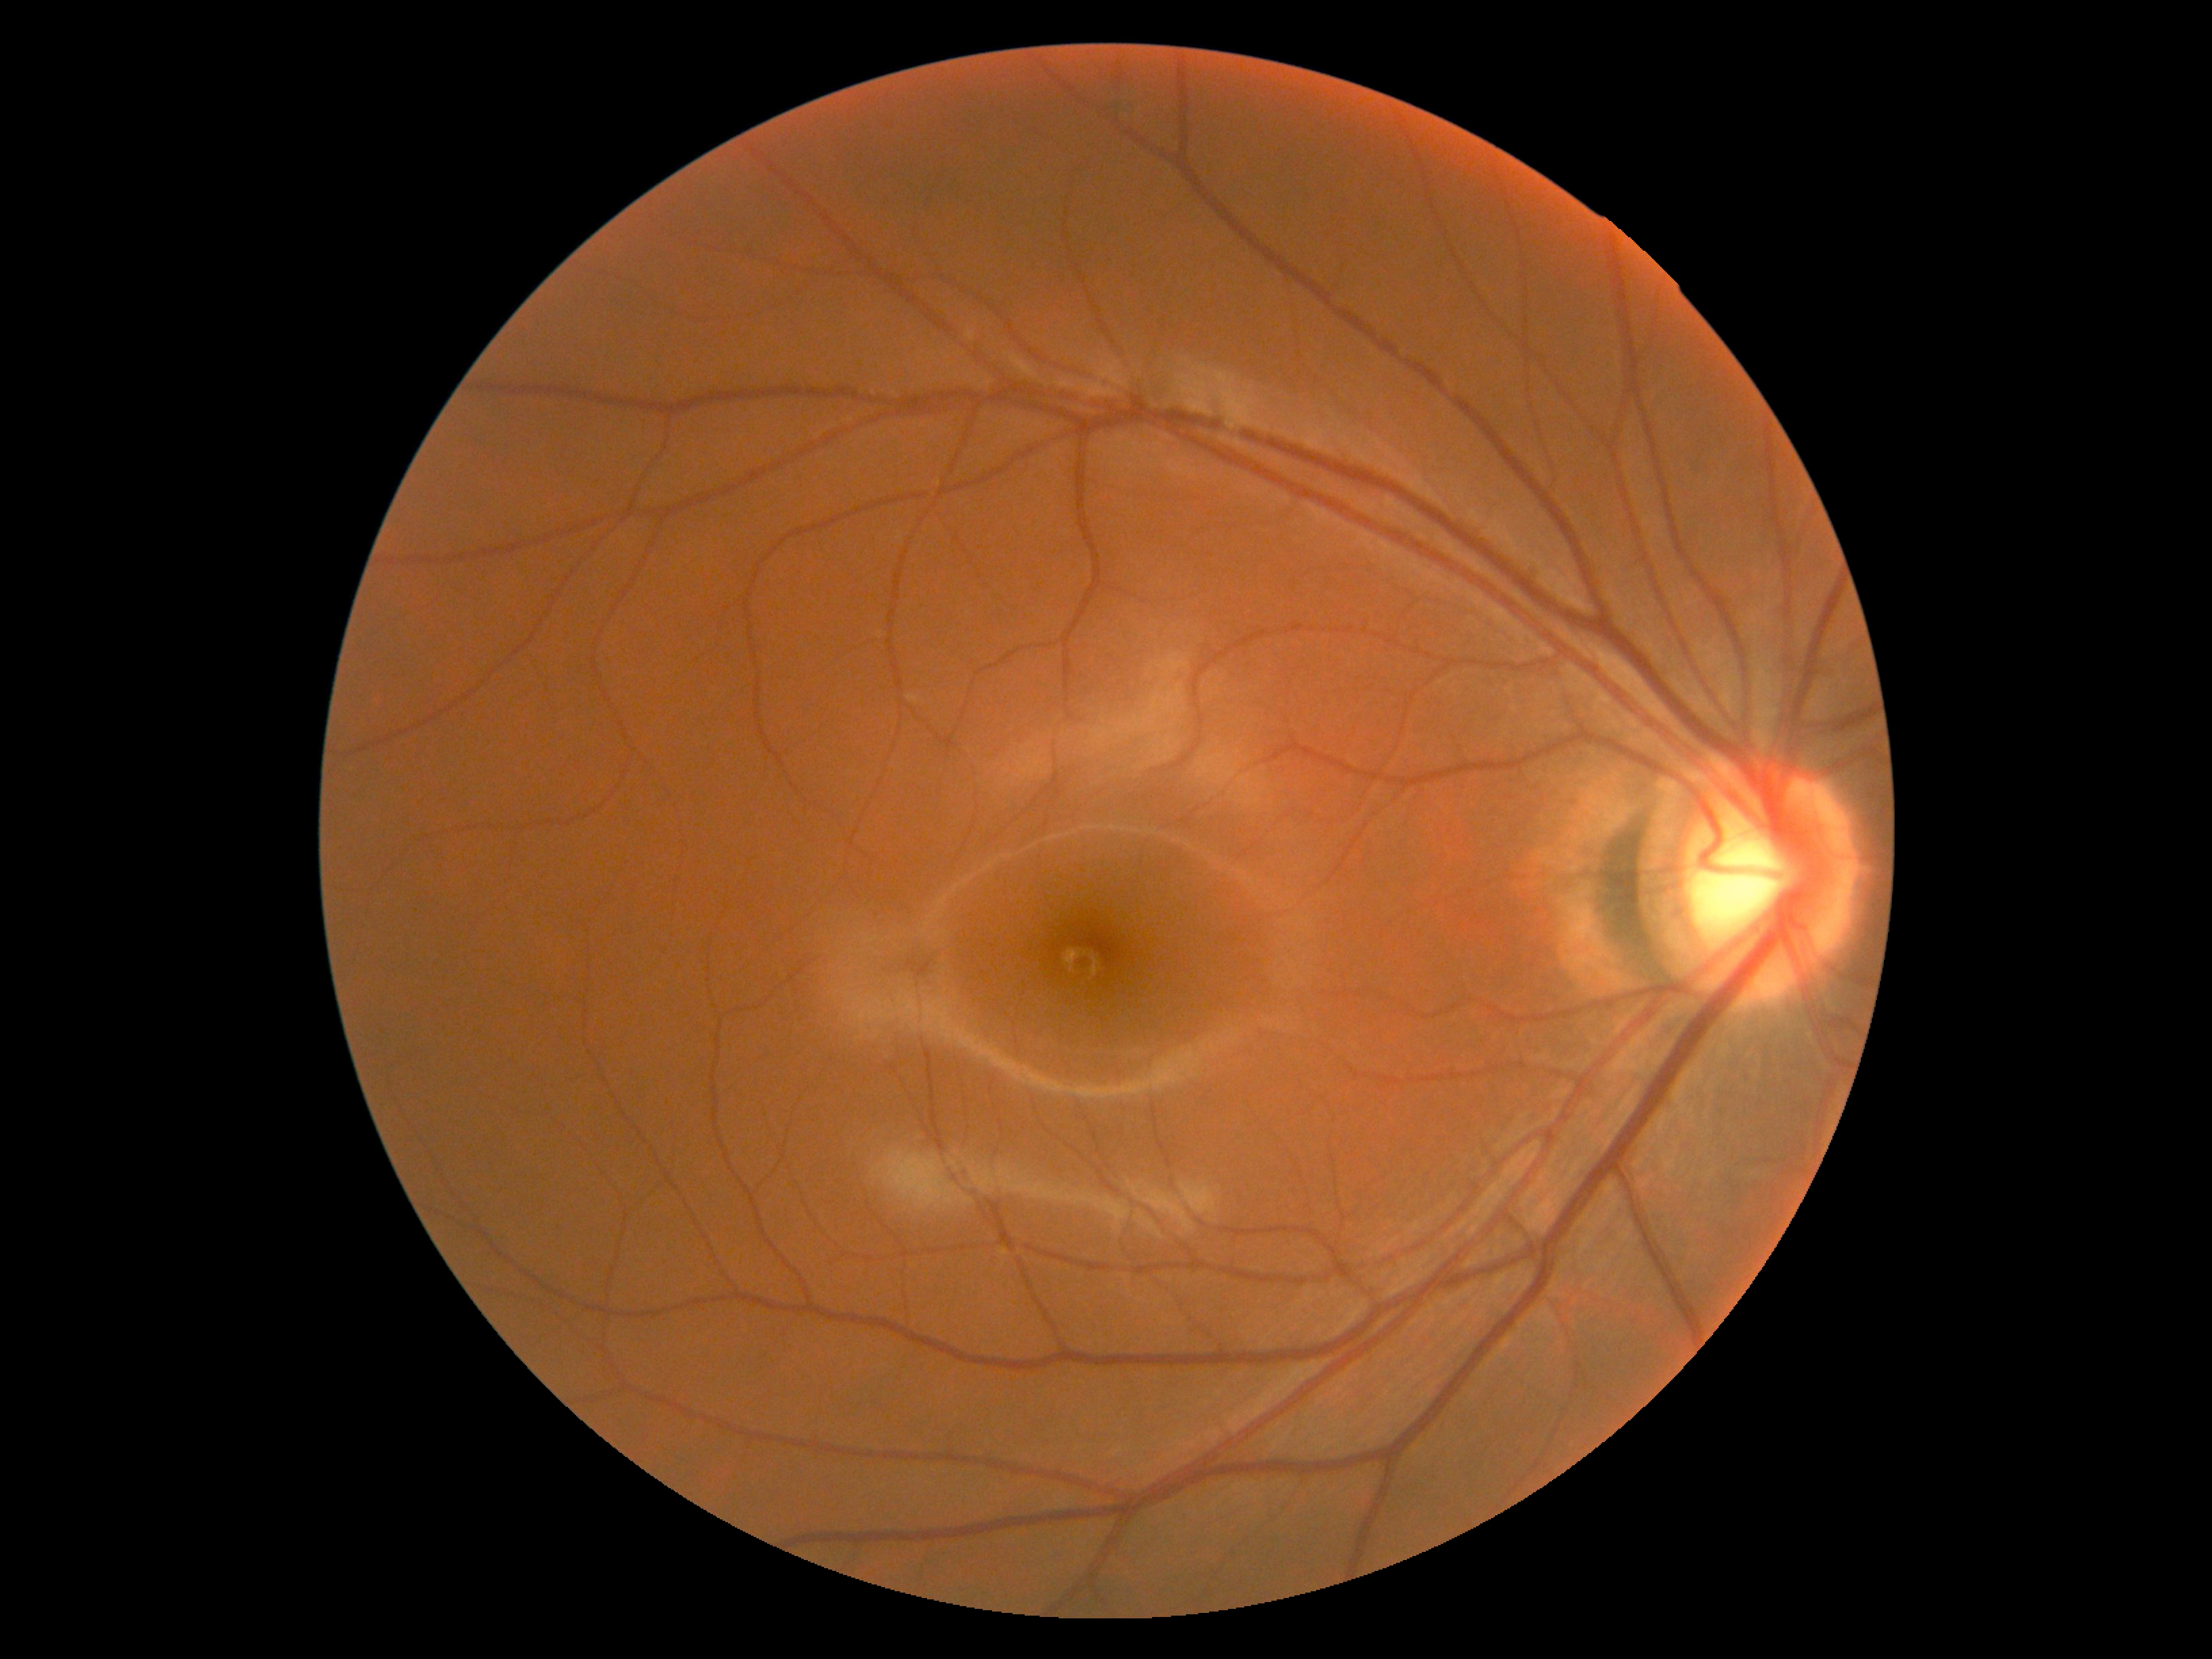

Retinopathy is no apparent retinopathy (grade 0).
No apparent diabetic retinopathy.